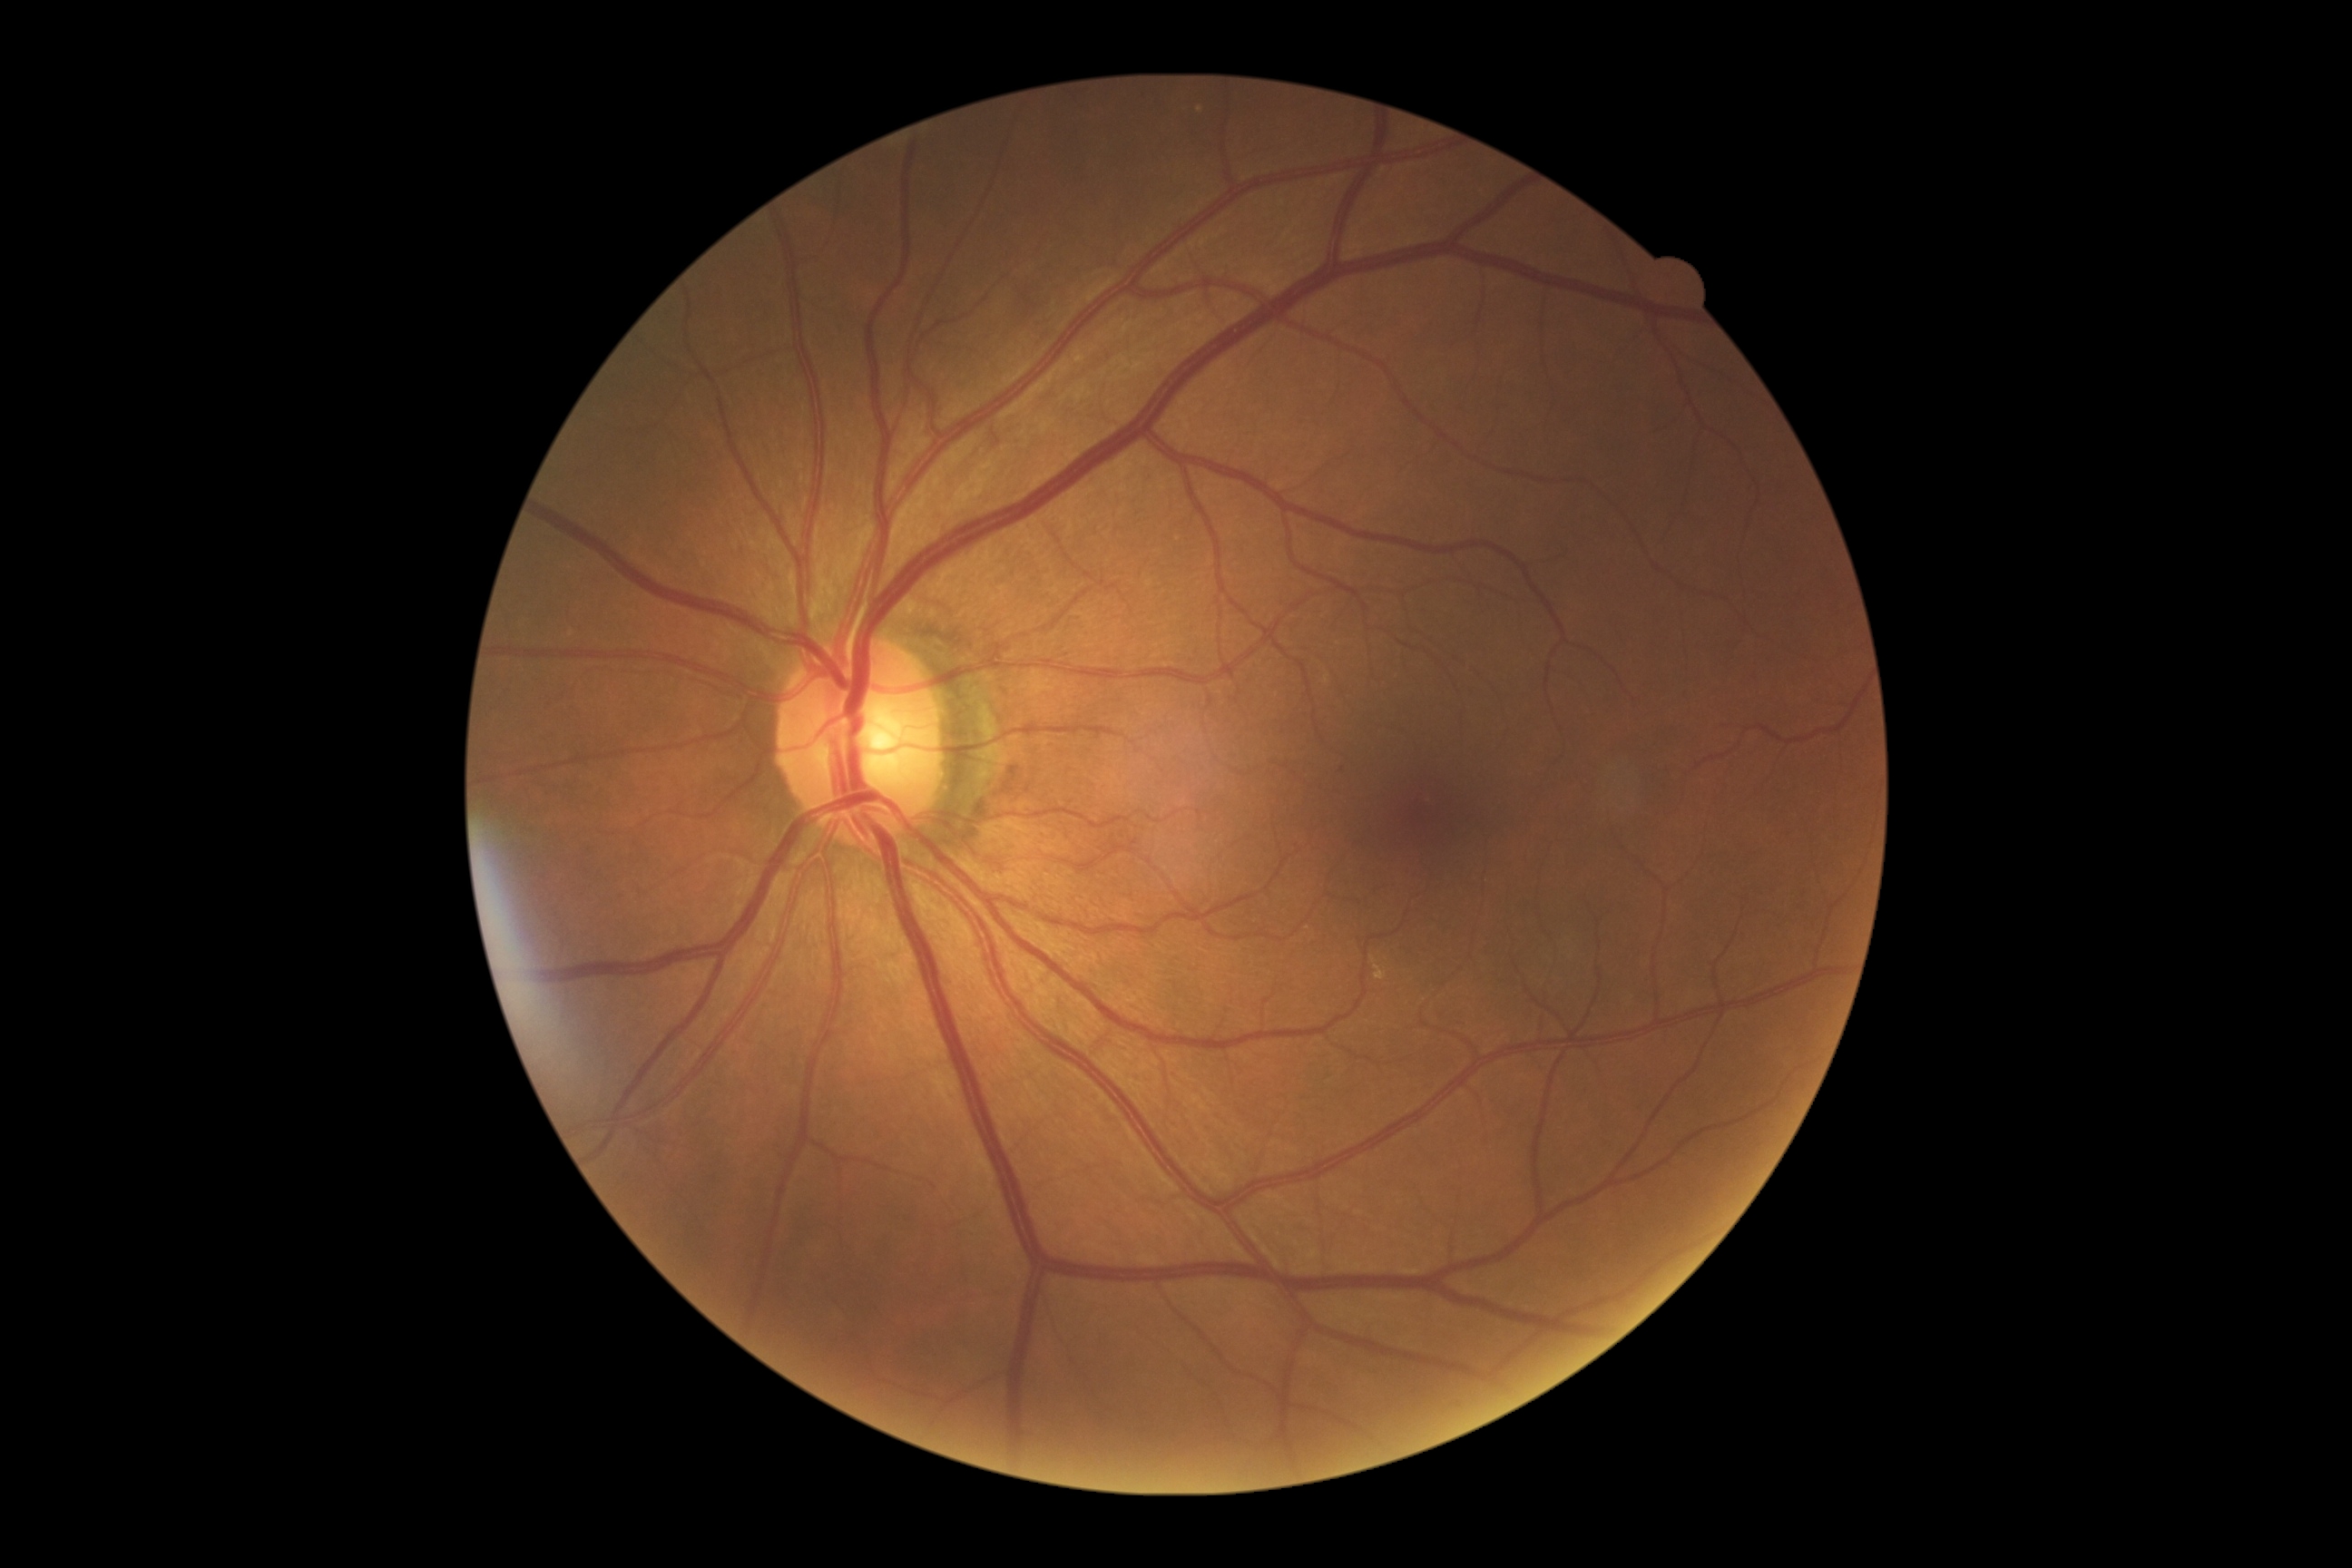 DR: grade 0 (no apparent retinopathy).